Wide-field fundus photograph of an infant · acquired on the Clarity RetCam 3 · 640 by 480 pixels:
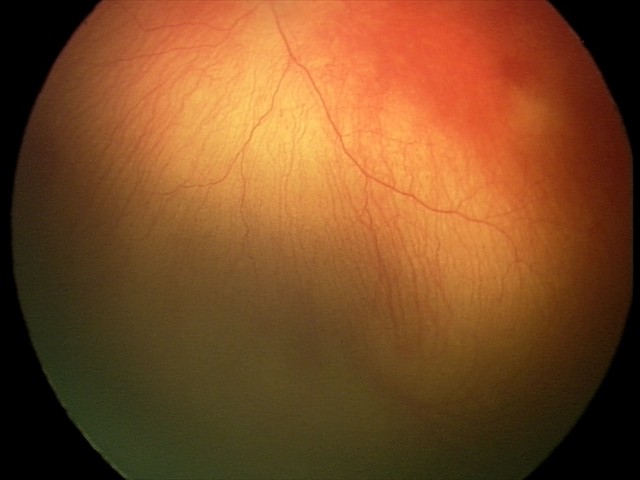

Plus disease present. Screening examination consistent with aggressive retinopathy of prematurity.